Color fundus image.
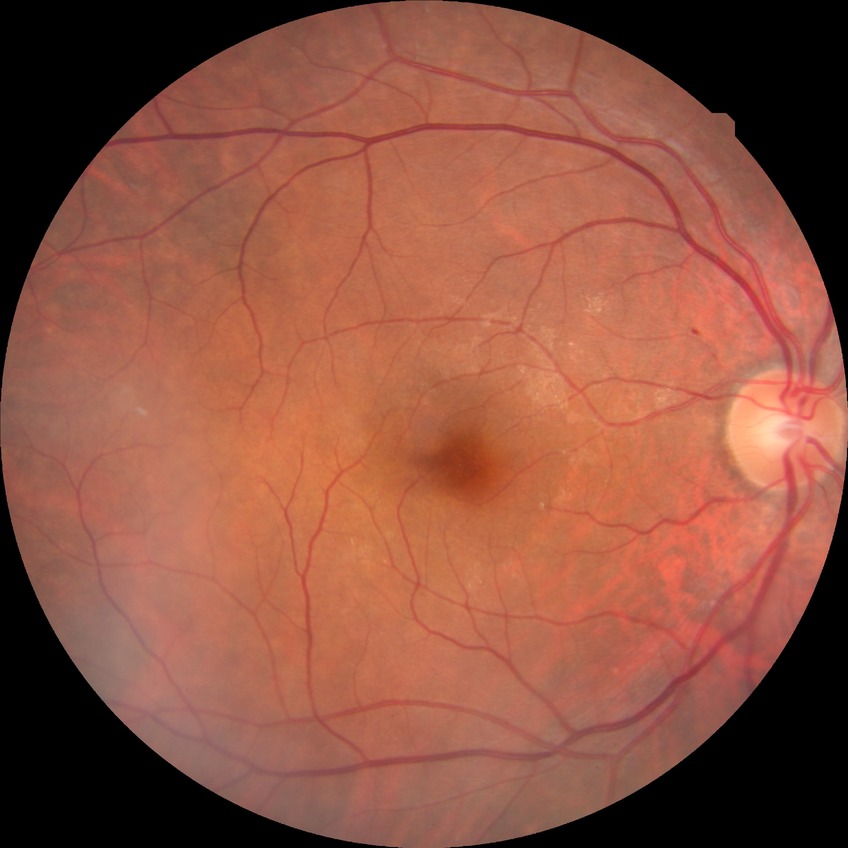

Davis grading: simple diabetic retinopathy.